Retinal fundus photograph
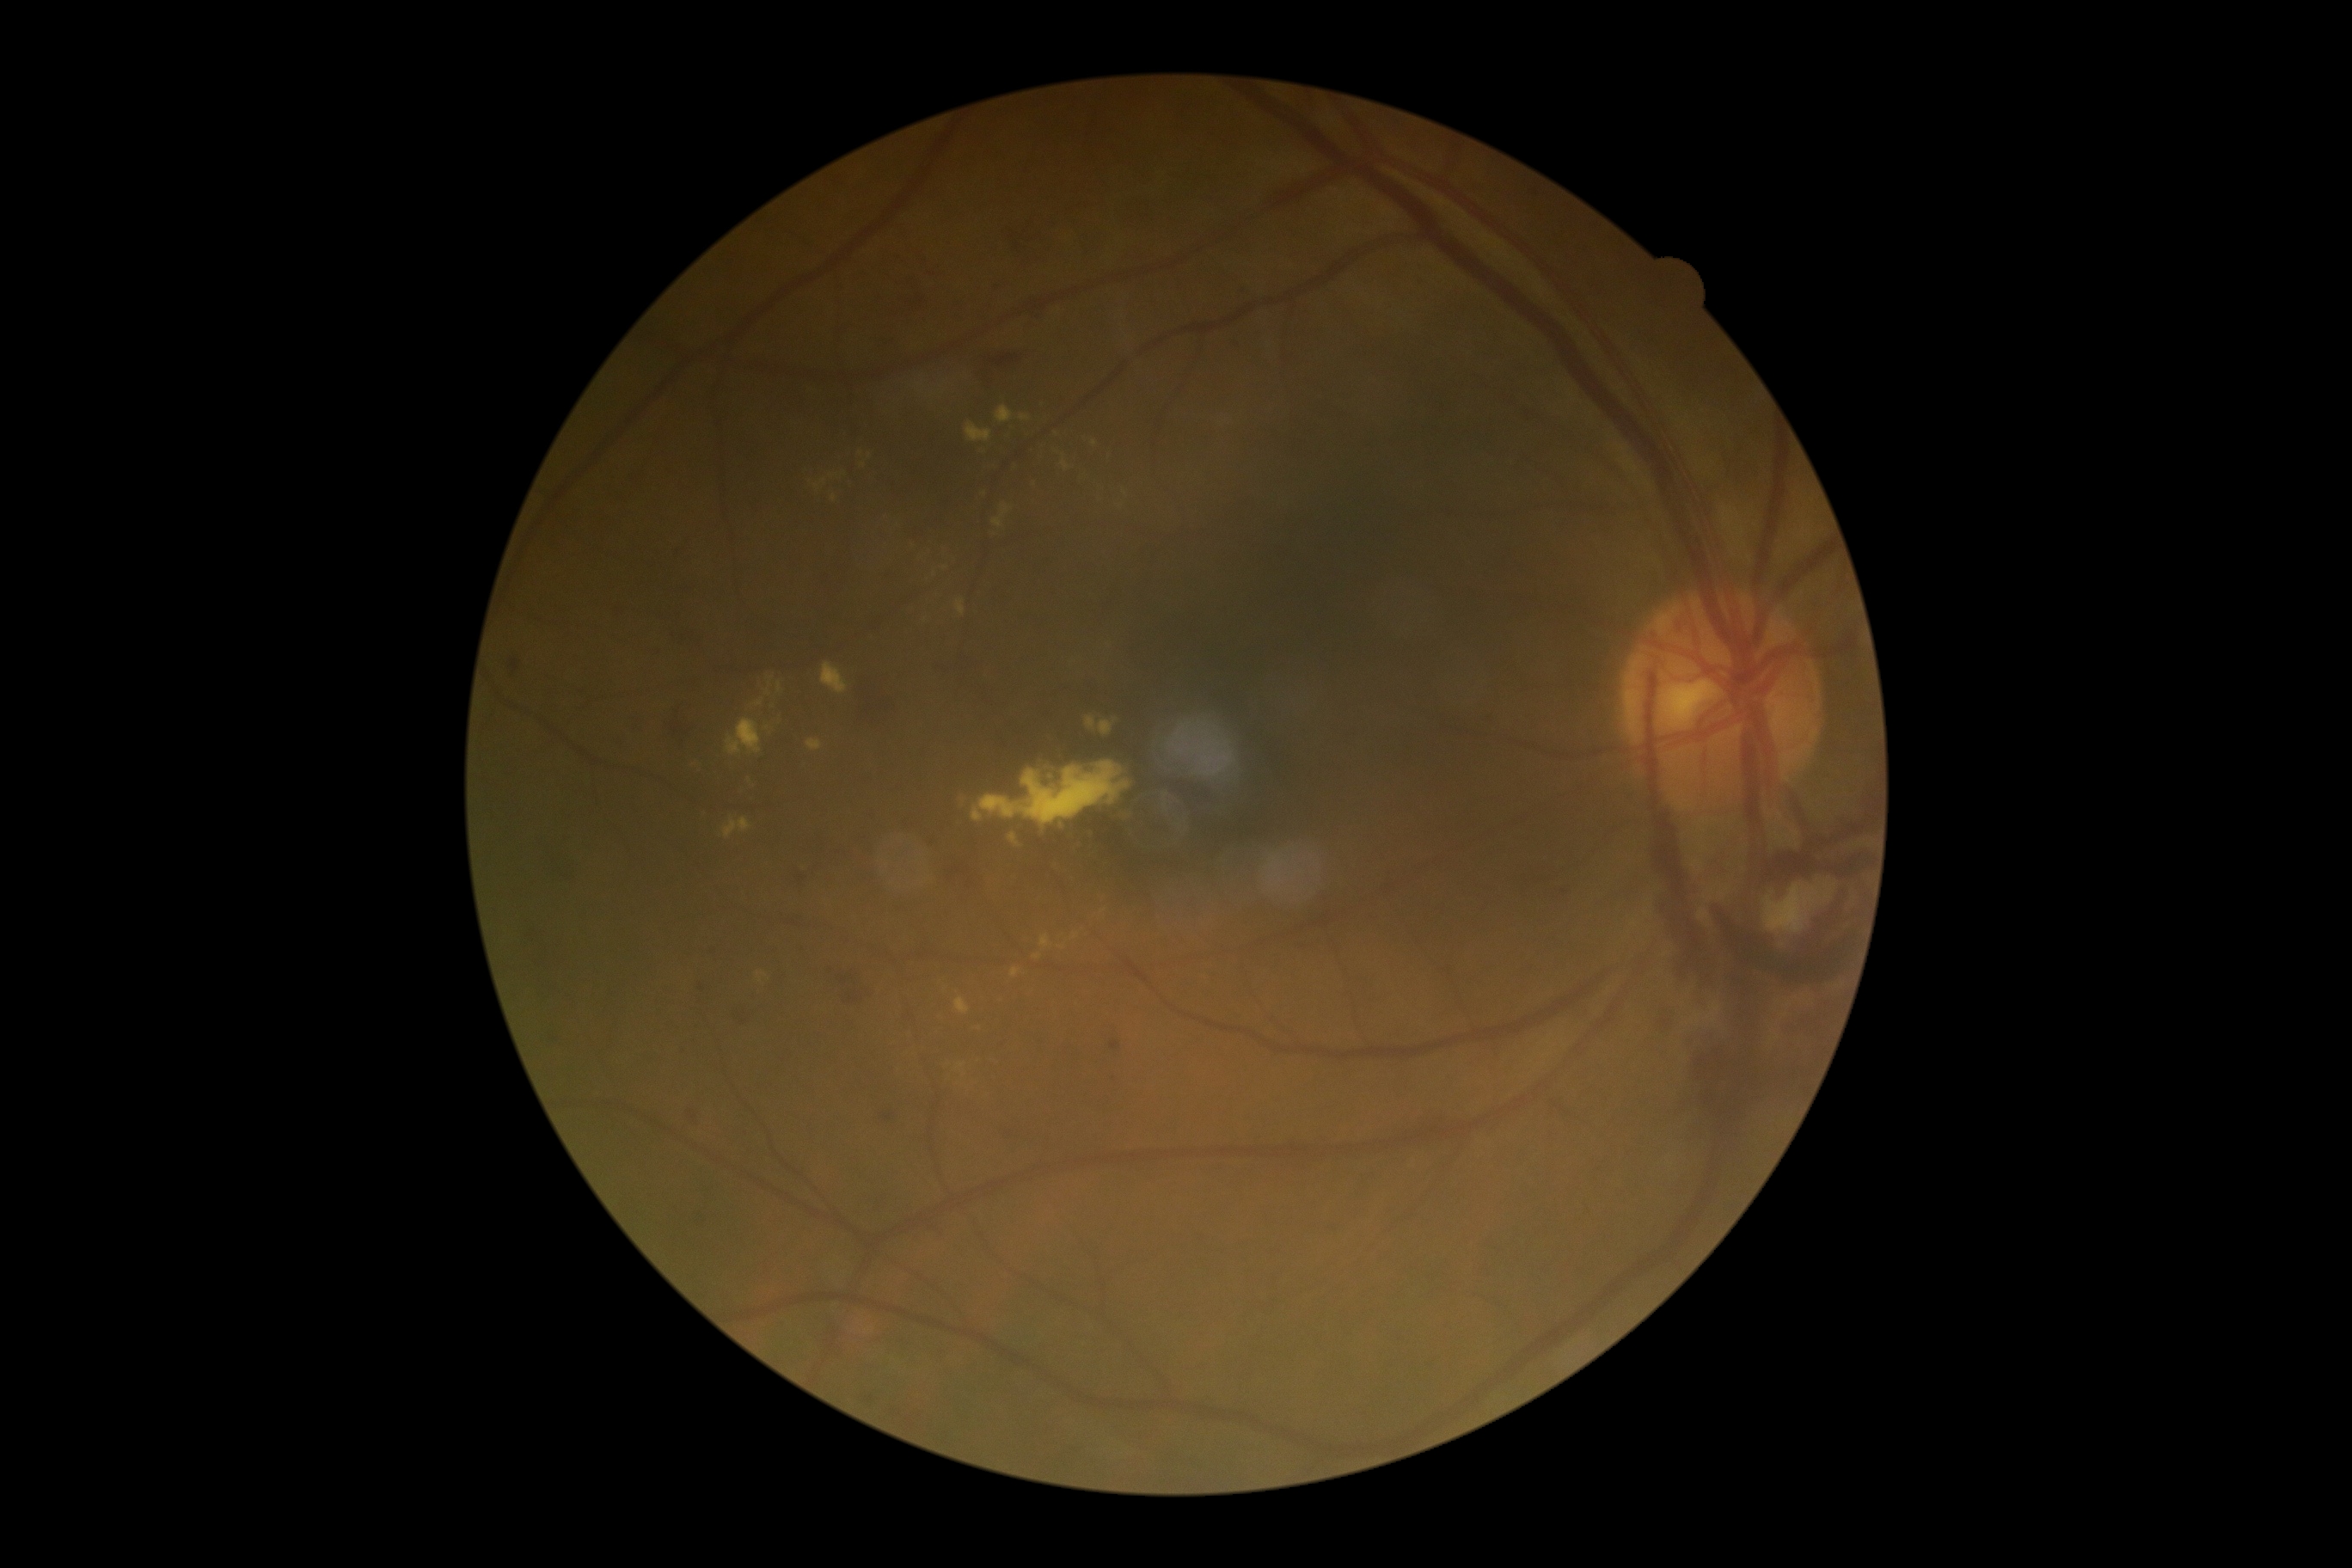 diabetic retinopathy severity: 4 — neovascularization and/or vitreous/pre-retinal hemorrhage; DR class: proliferative diabetic retinopathy.